Portable fundus camera image:
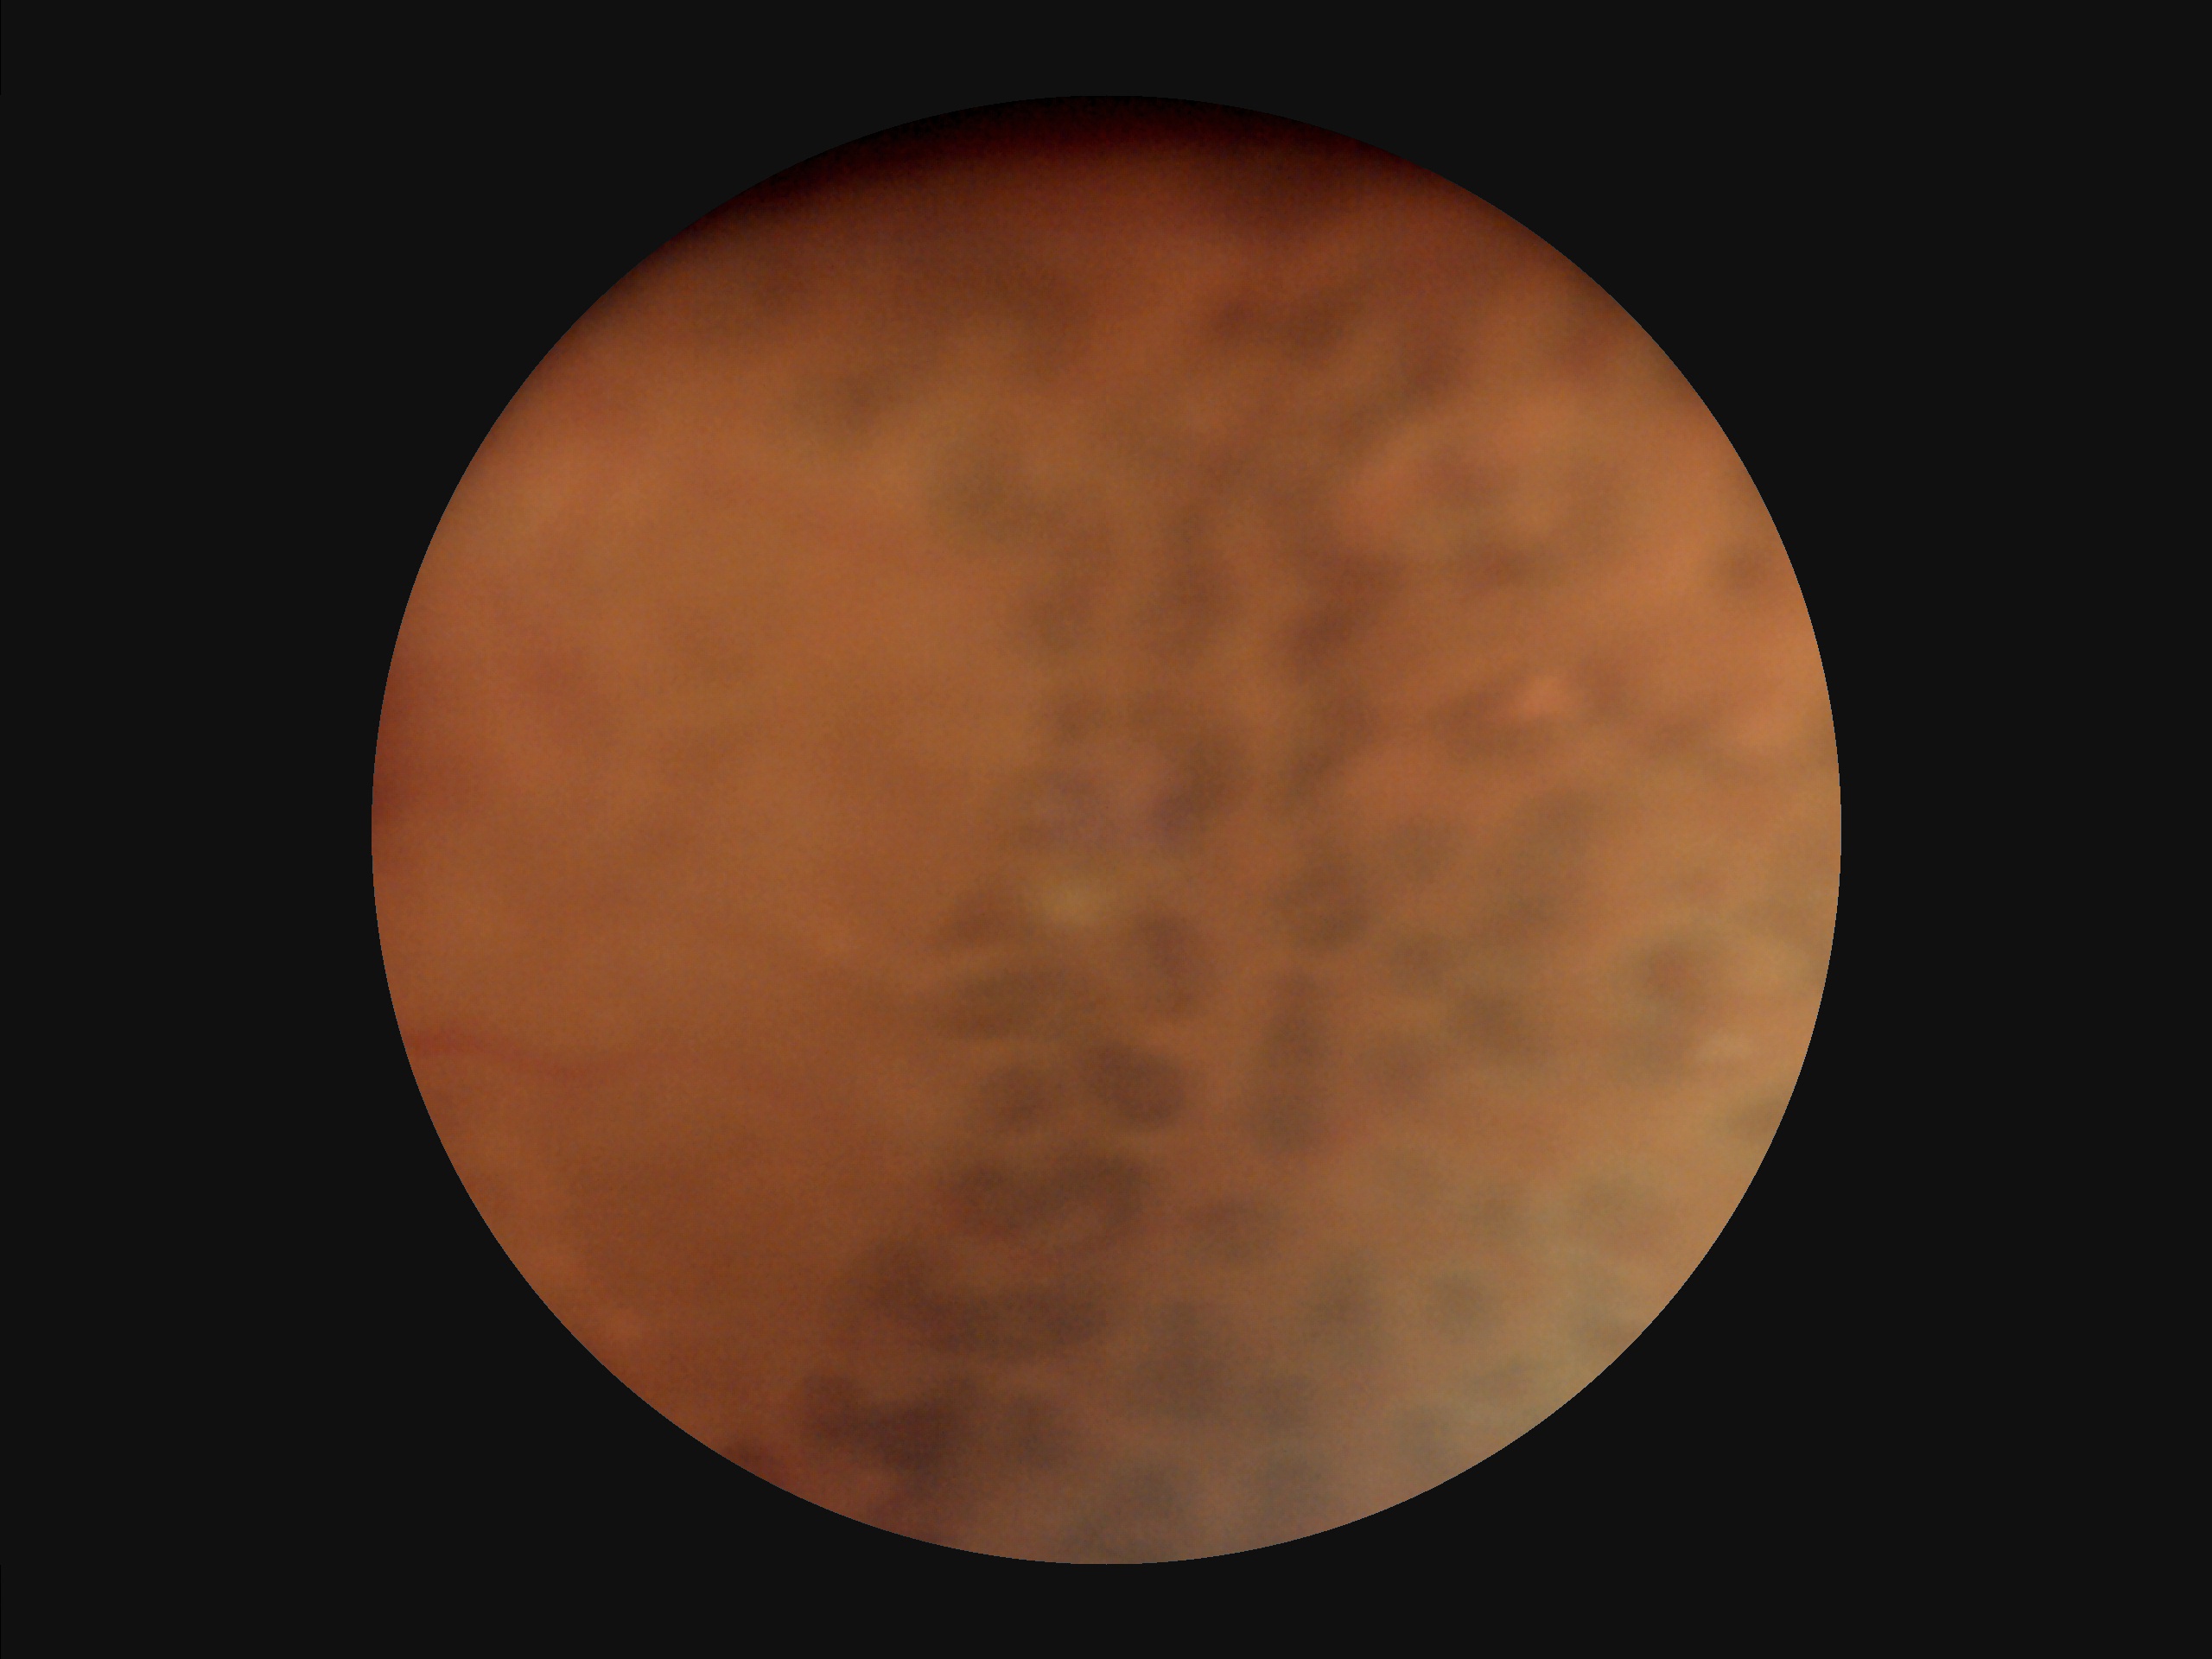
Overall image quality: poor, ungradable
Sharpness: reduced sharpness with visible blur
Contrast: low, vessels and details hard to distinguish
Illumination: even and well-balanced